Infant wide-field retinal image — 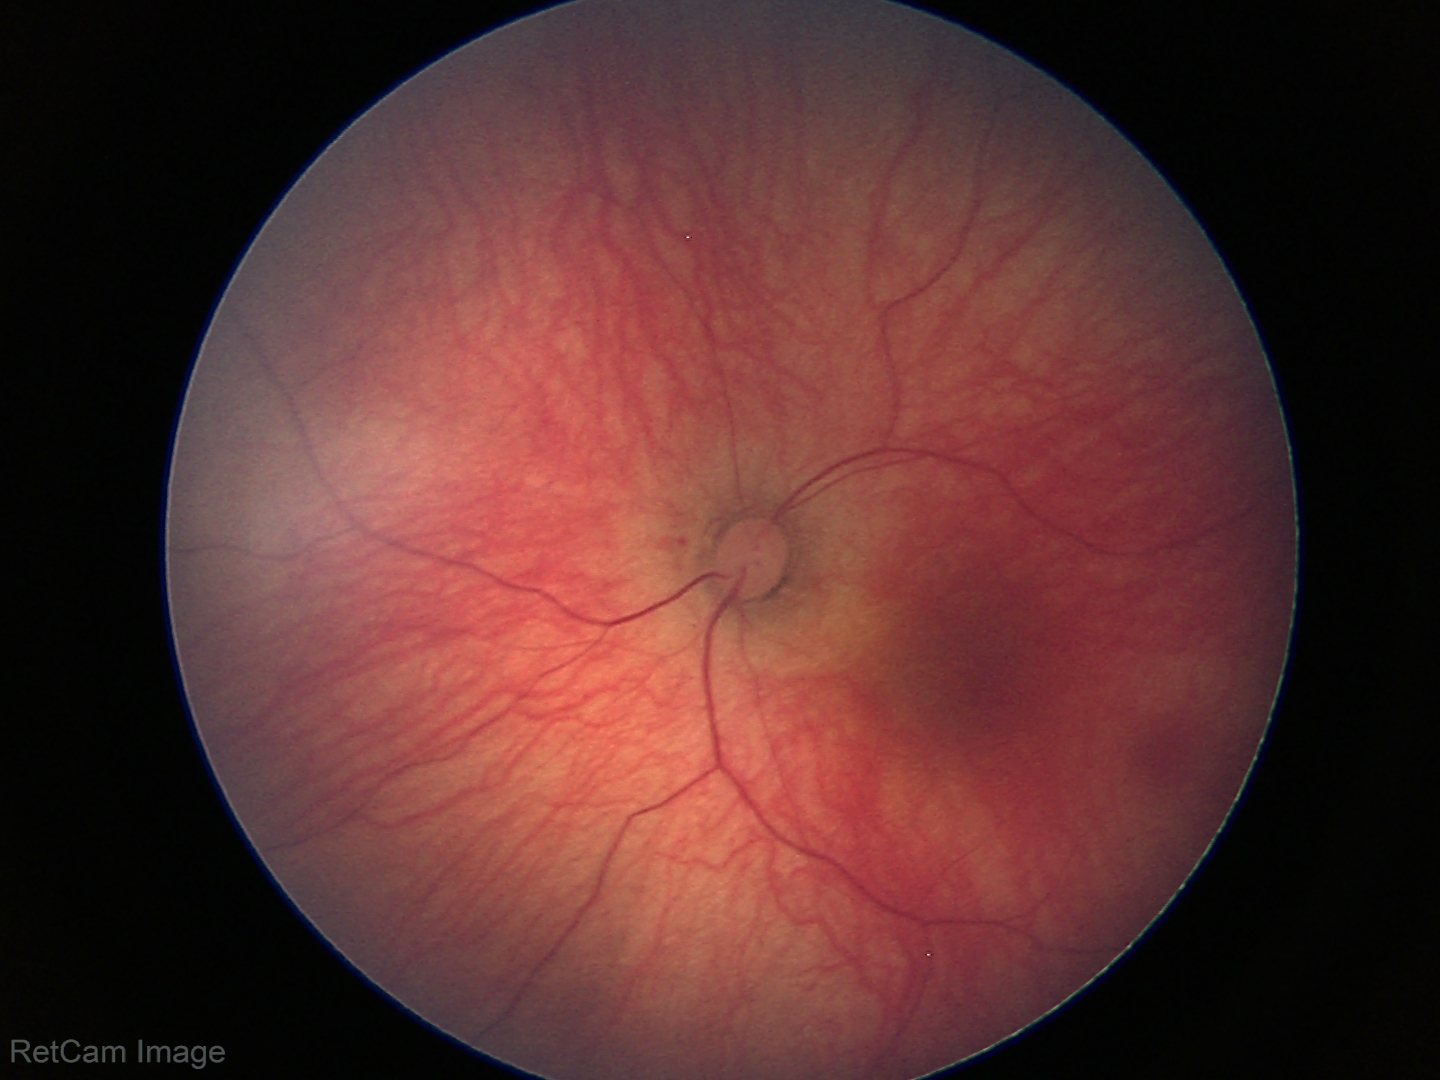 Screening examination with no abnormal retinal findings.